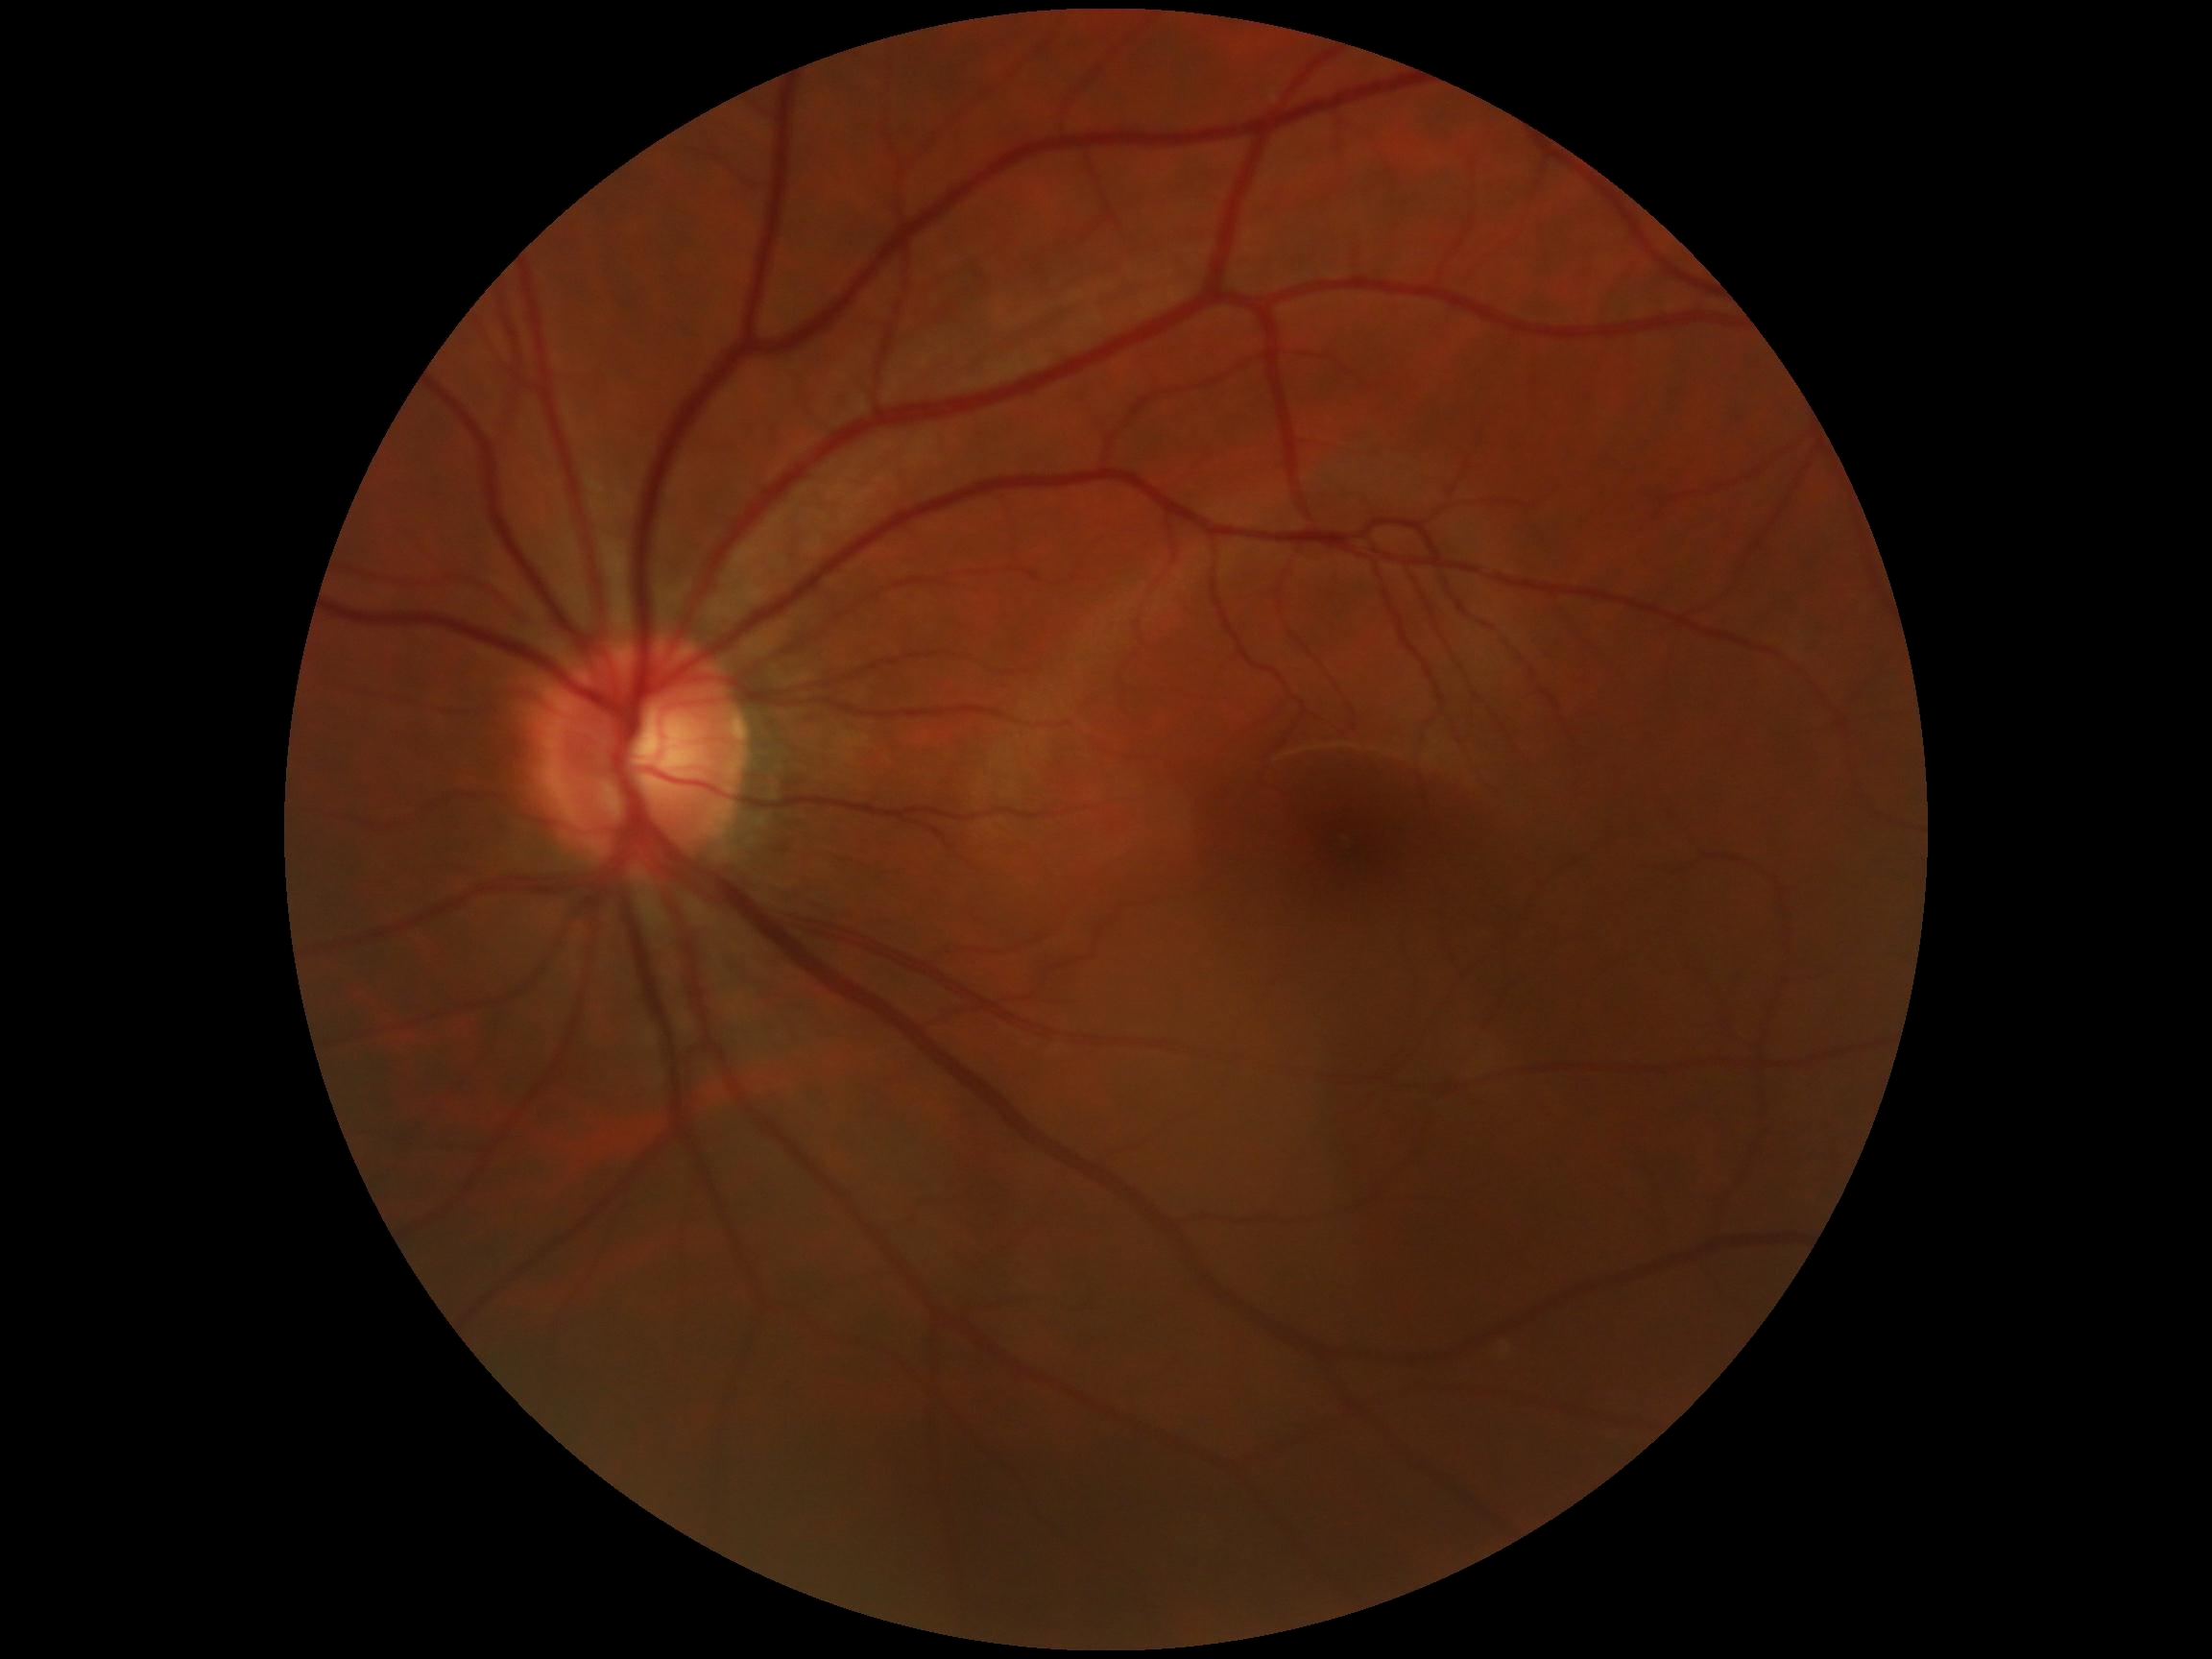

{"dr_grade": "grade 0 (no apparent retinopathy)"}